Optic disc-centered crop from a color fundus photograph; dilated pupil; 439x439px — 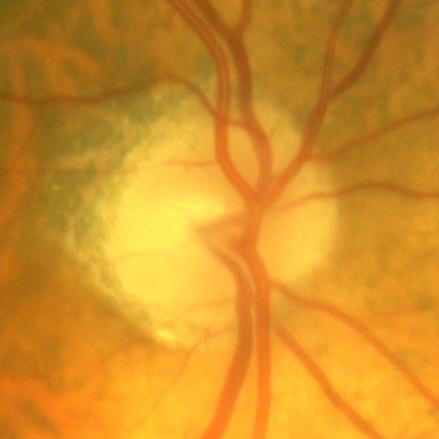
Optic disc appearance consistent with no glaucomatous findings.